Fundus photo taken with a portable handheld camera
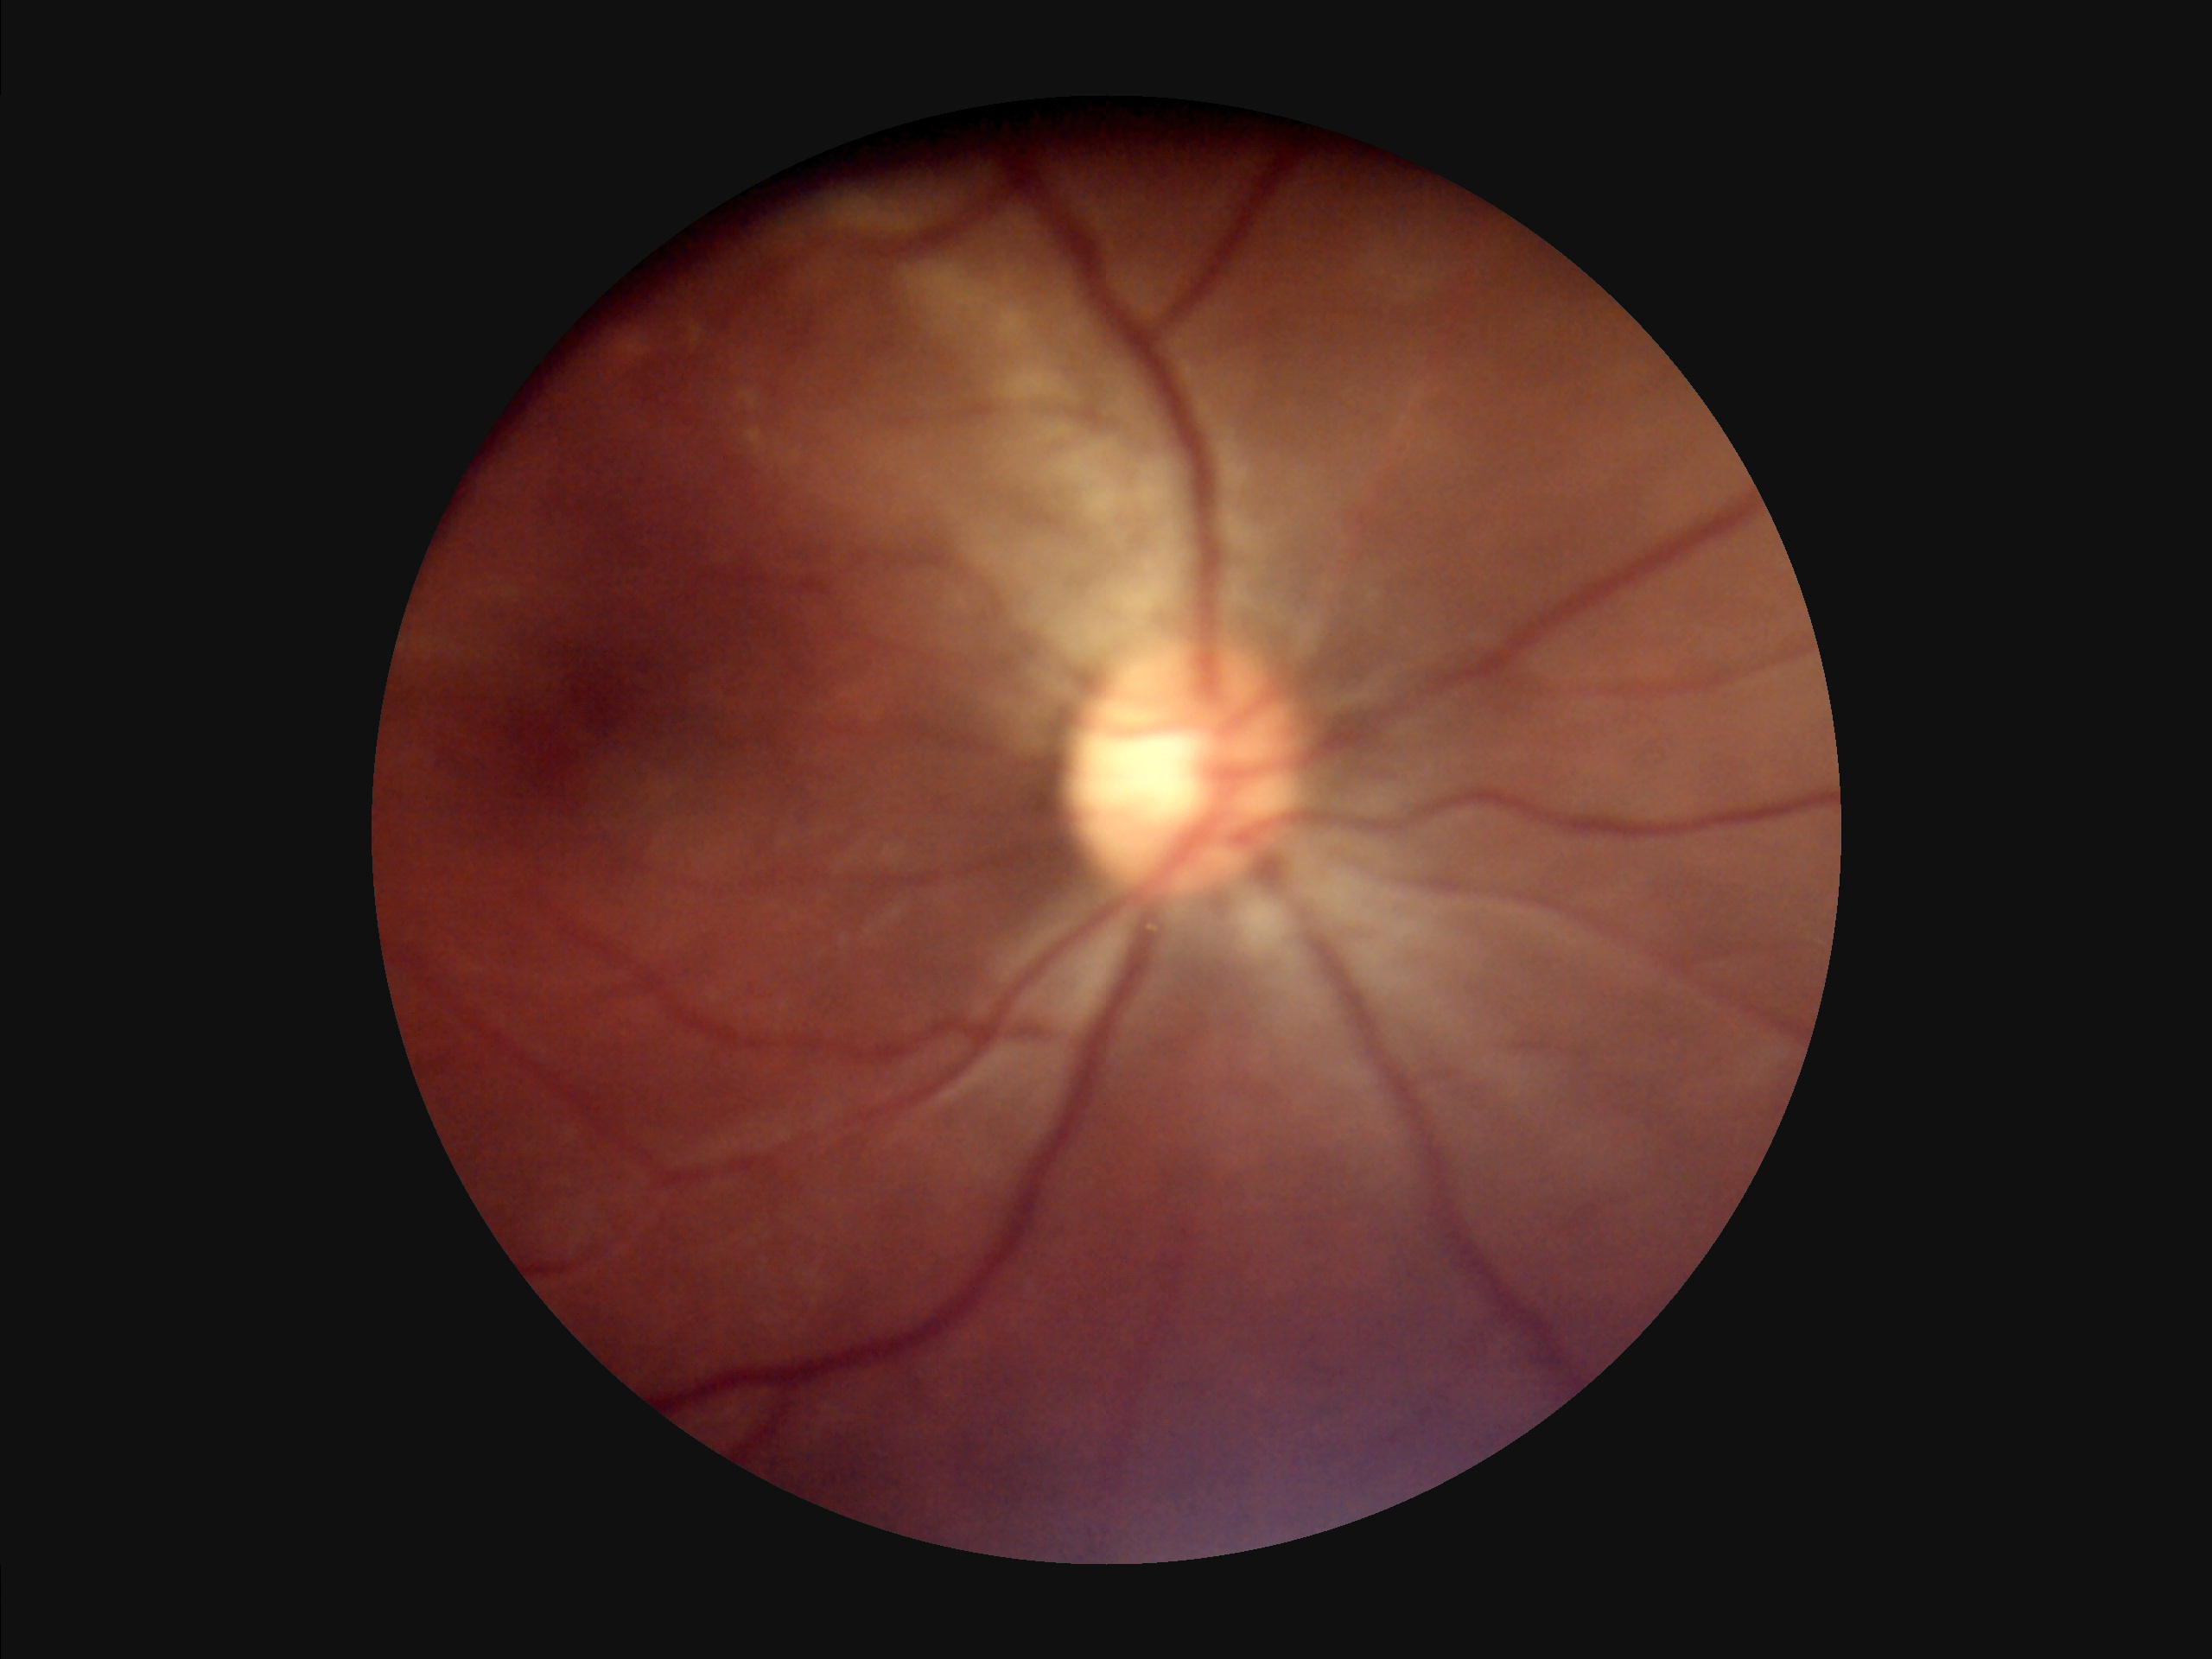

Out of focus; structures are indistinct.
No over- or under-exposure.
Image quality is suboptimal.